Infant wide-field retinal image. Image size 1240x1240 — 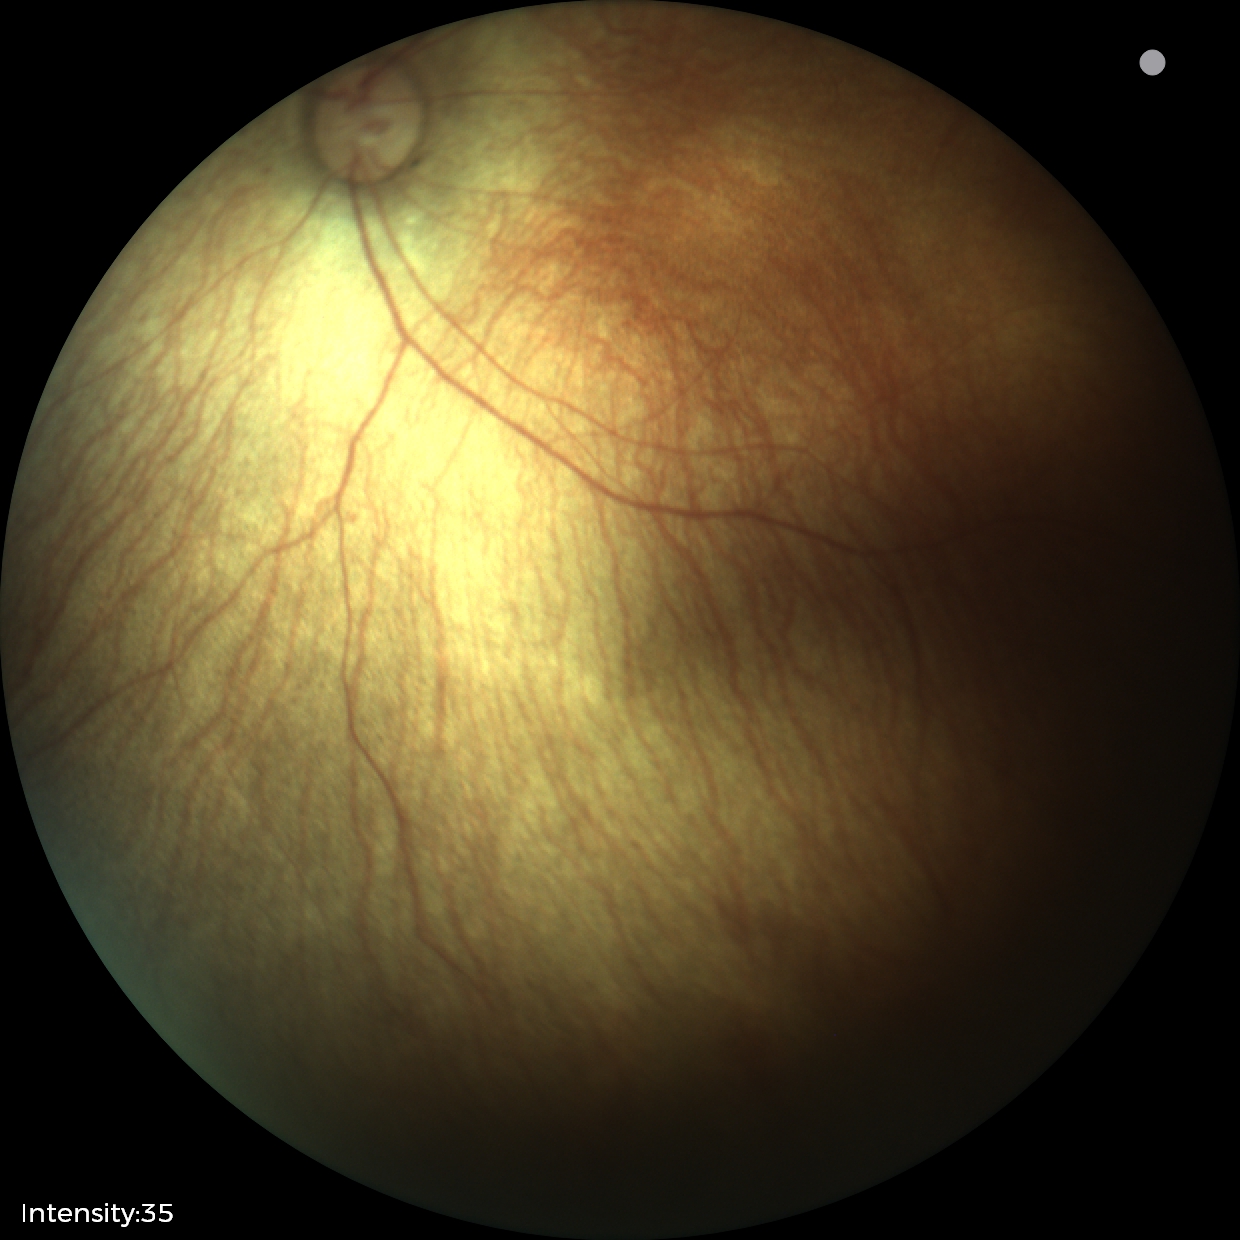

Screening examination diagnosed as physiological.